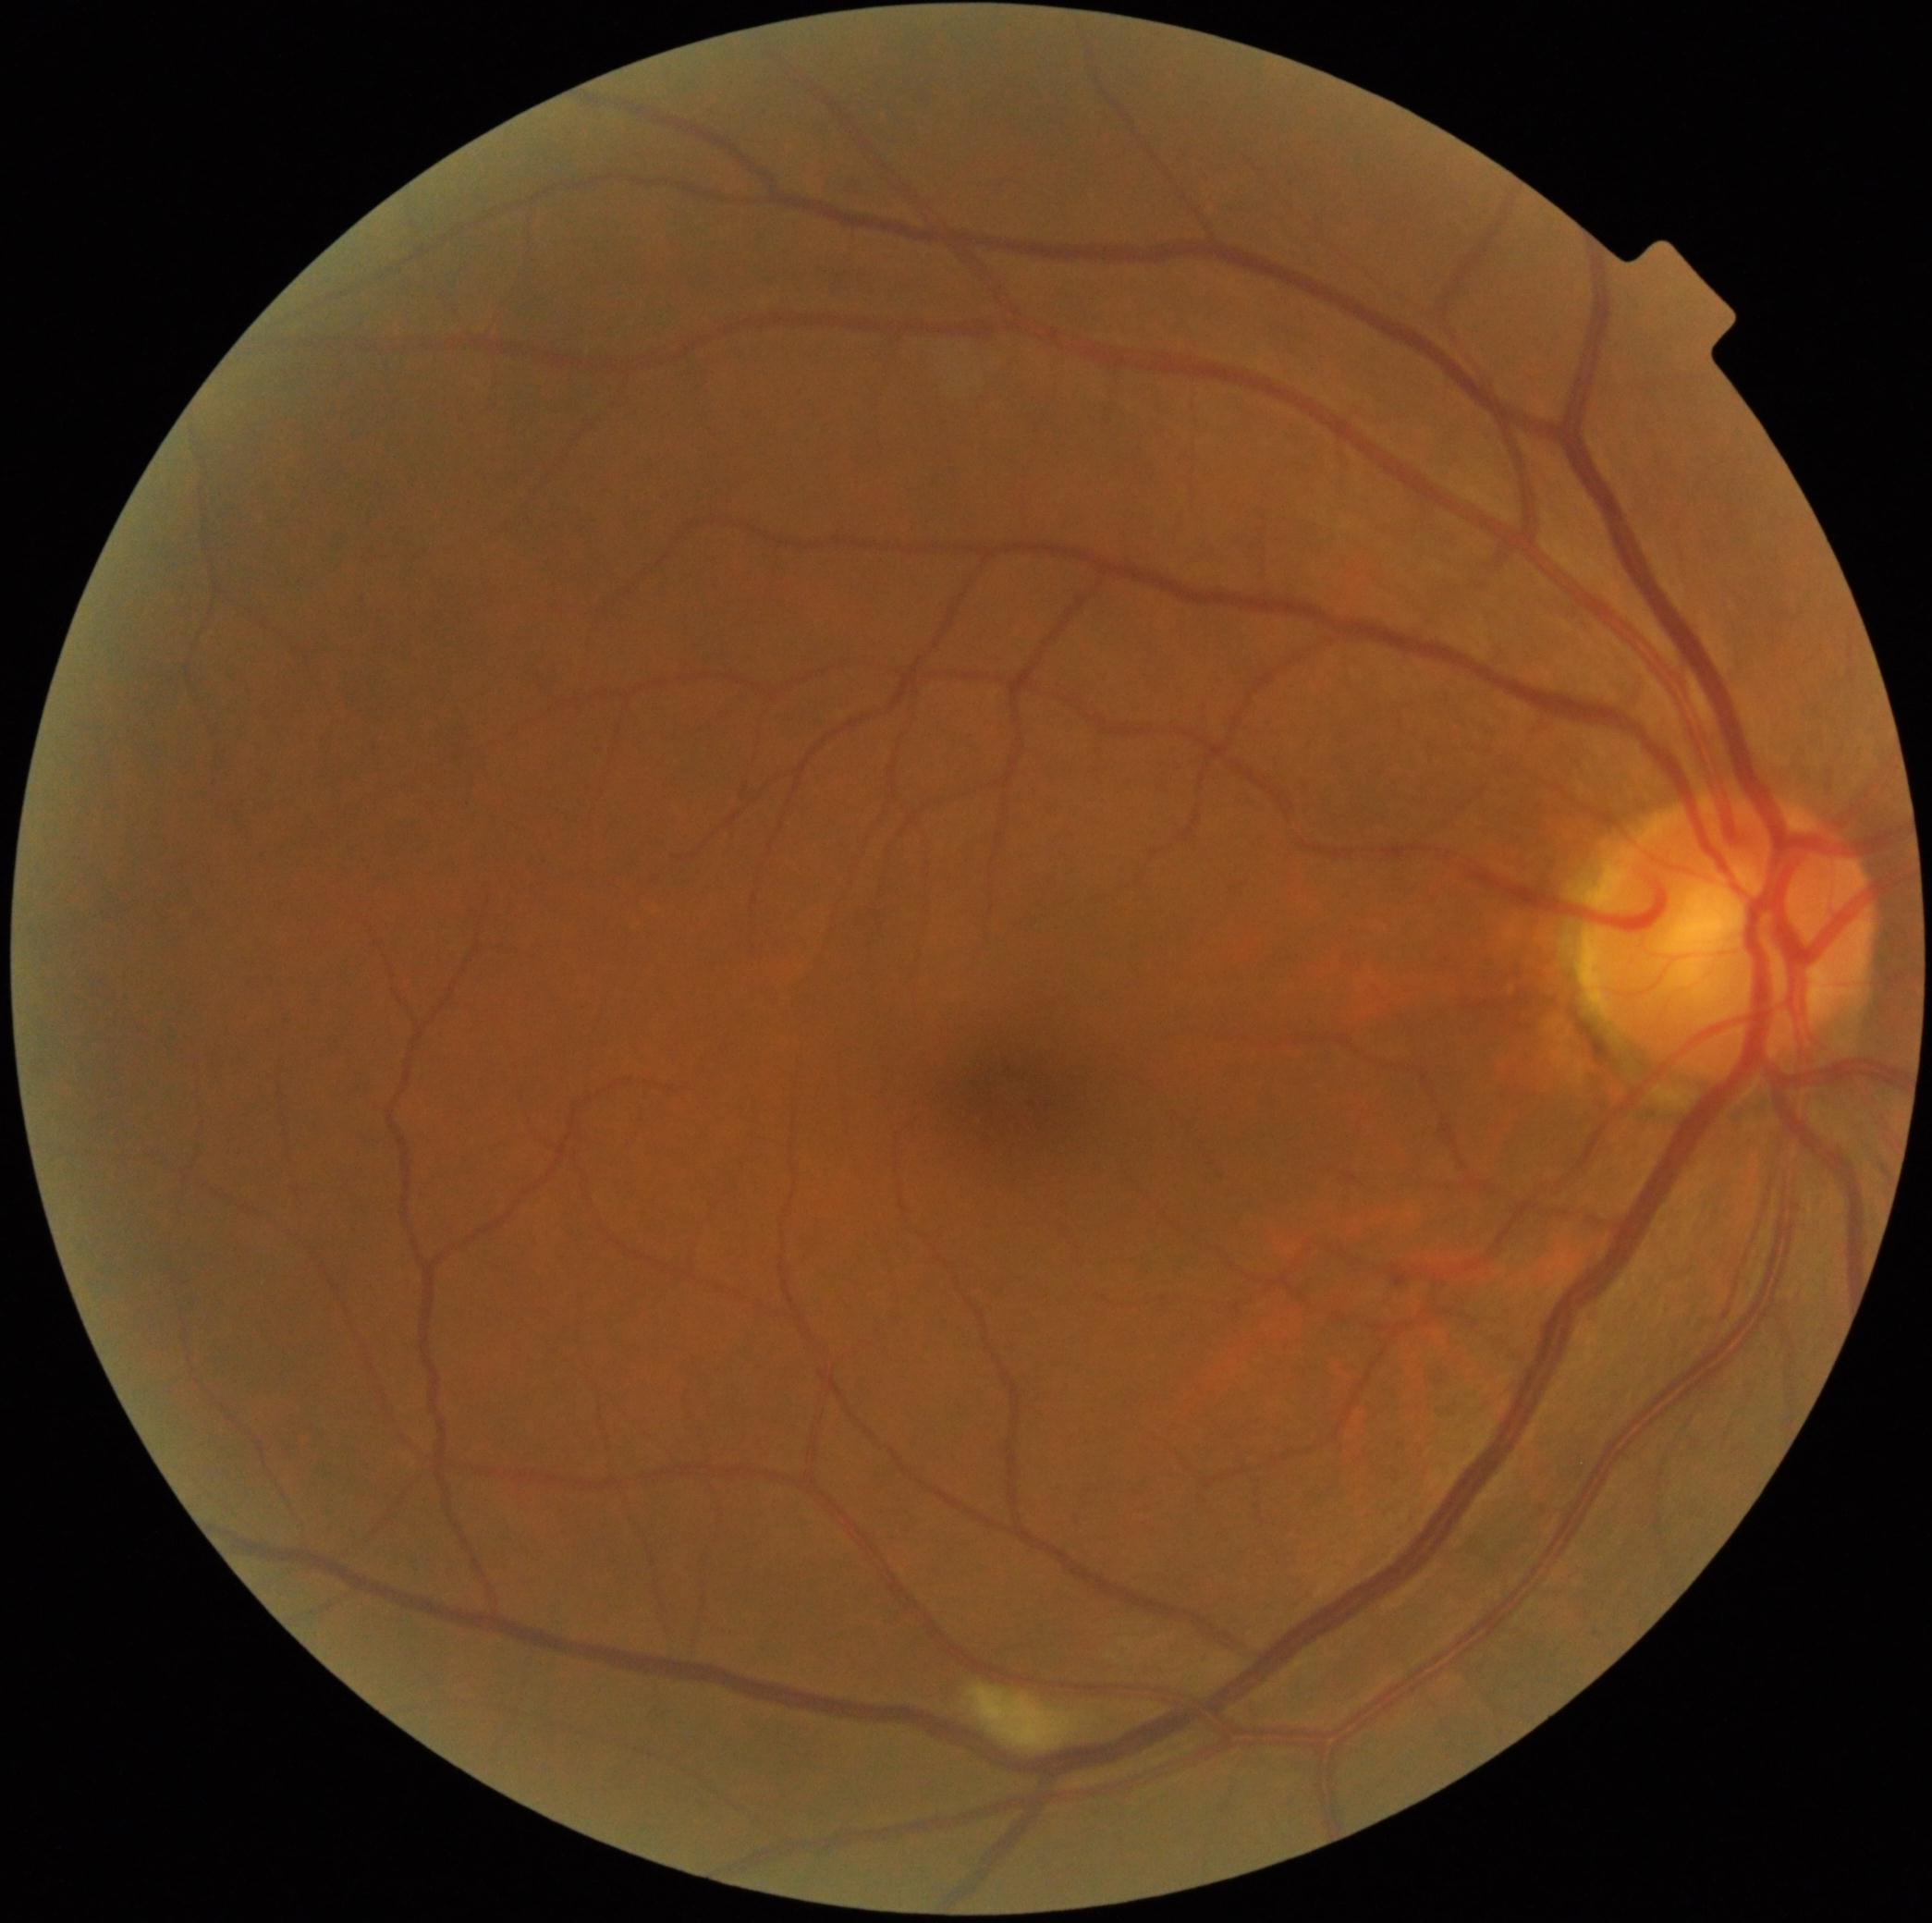

Annotations:
* retinopathy grade: 2